Wide-field fundus photograph of an infant:
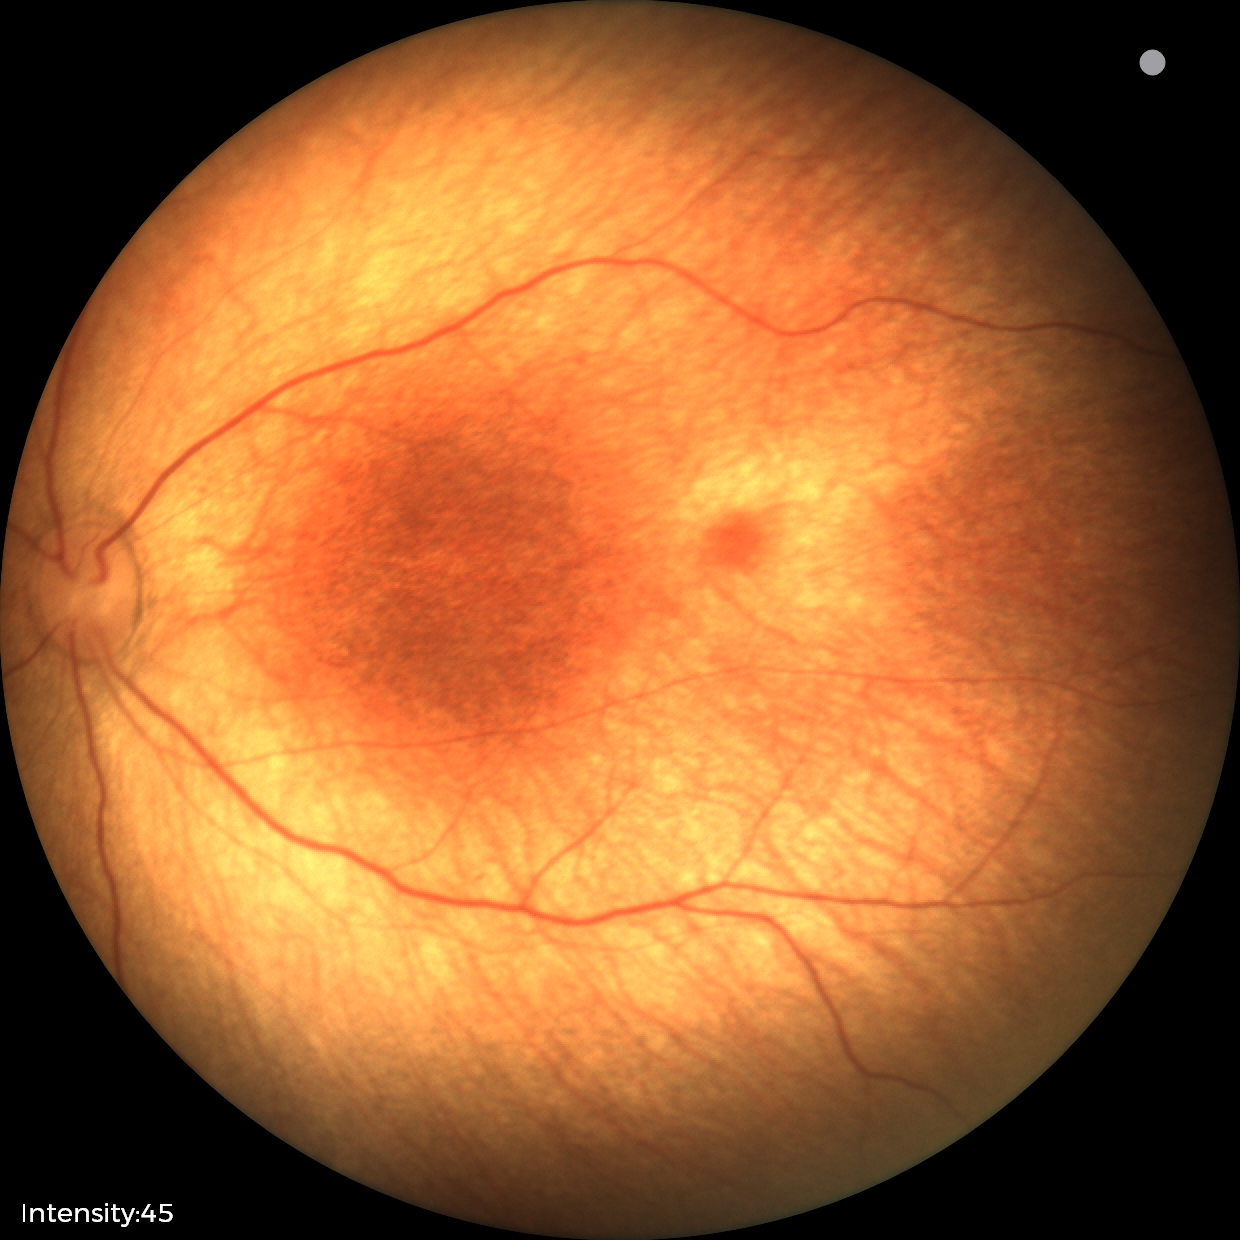 Assessment: physiological.